45° FOV — 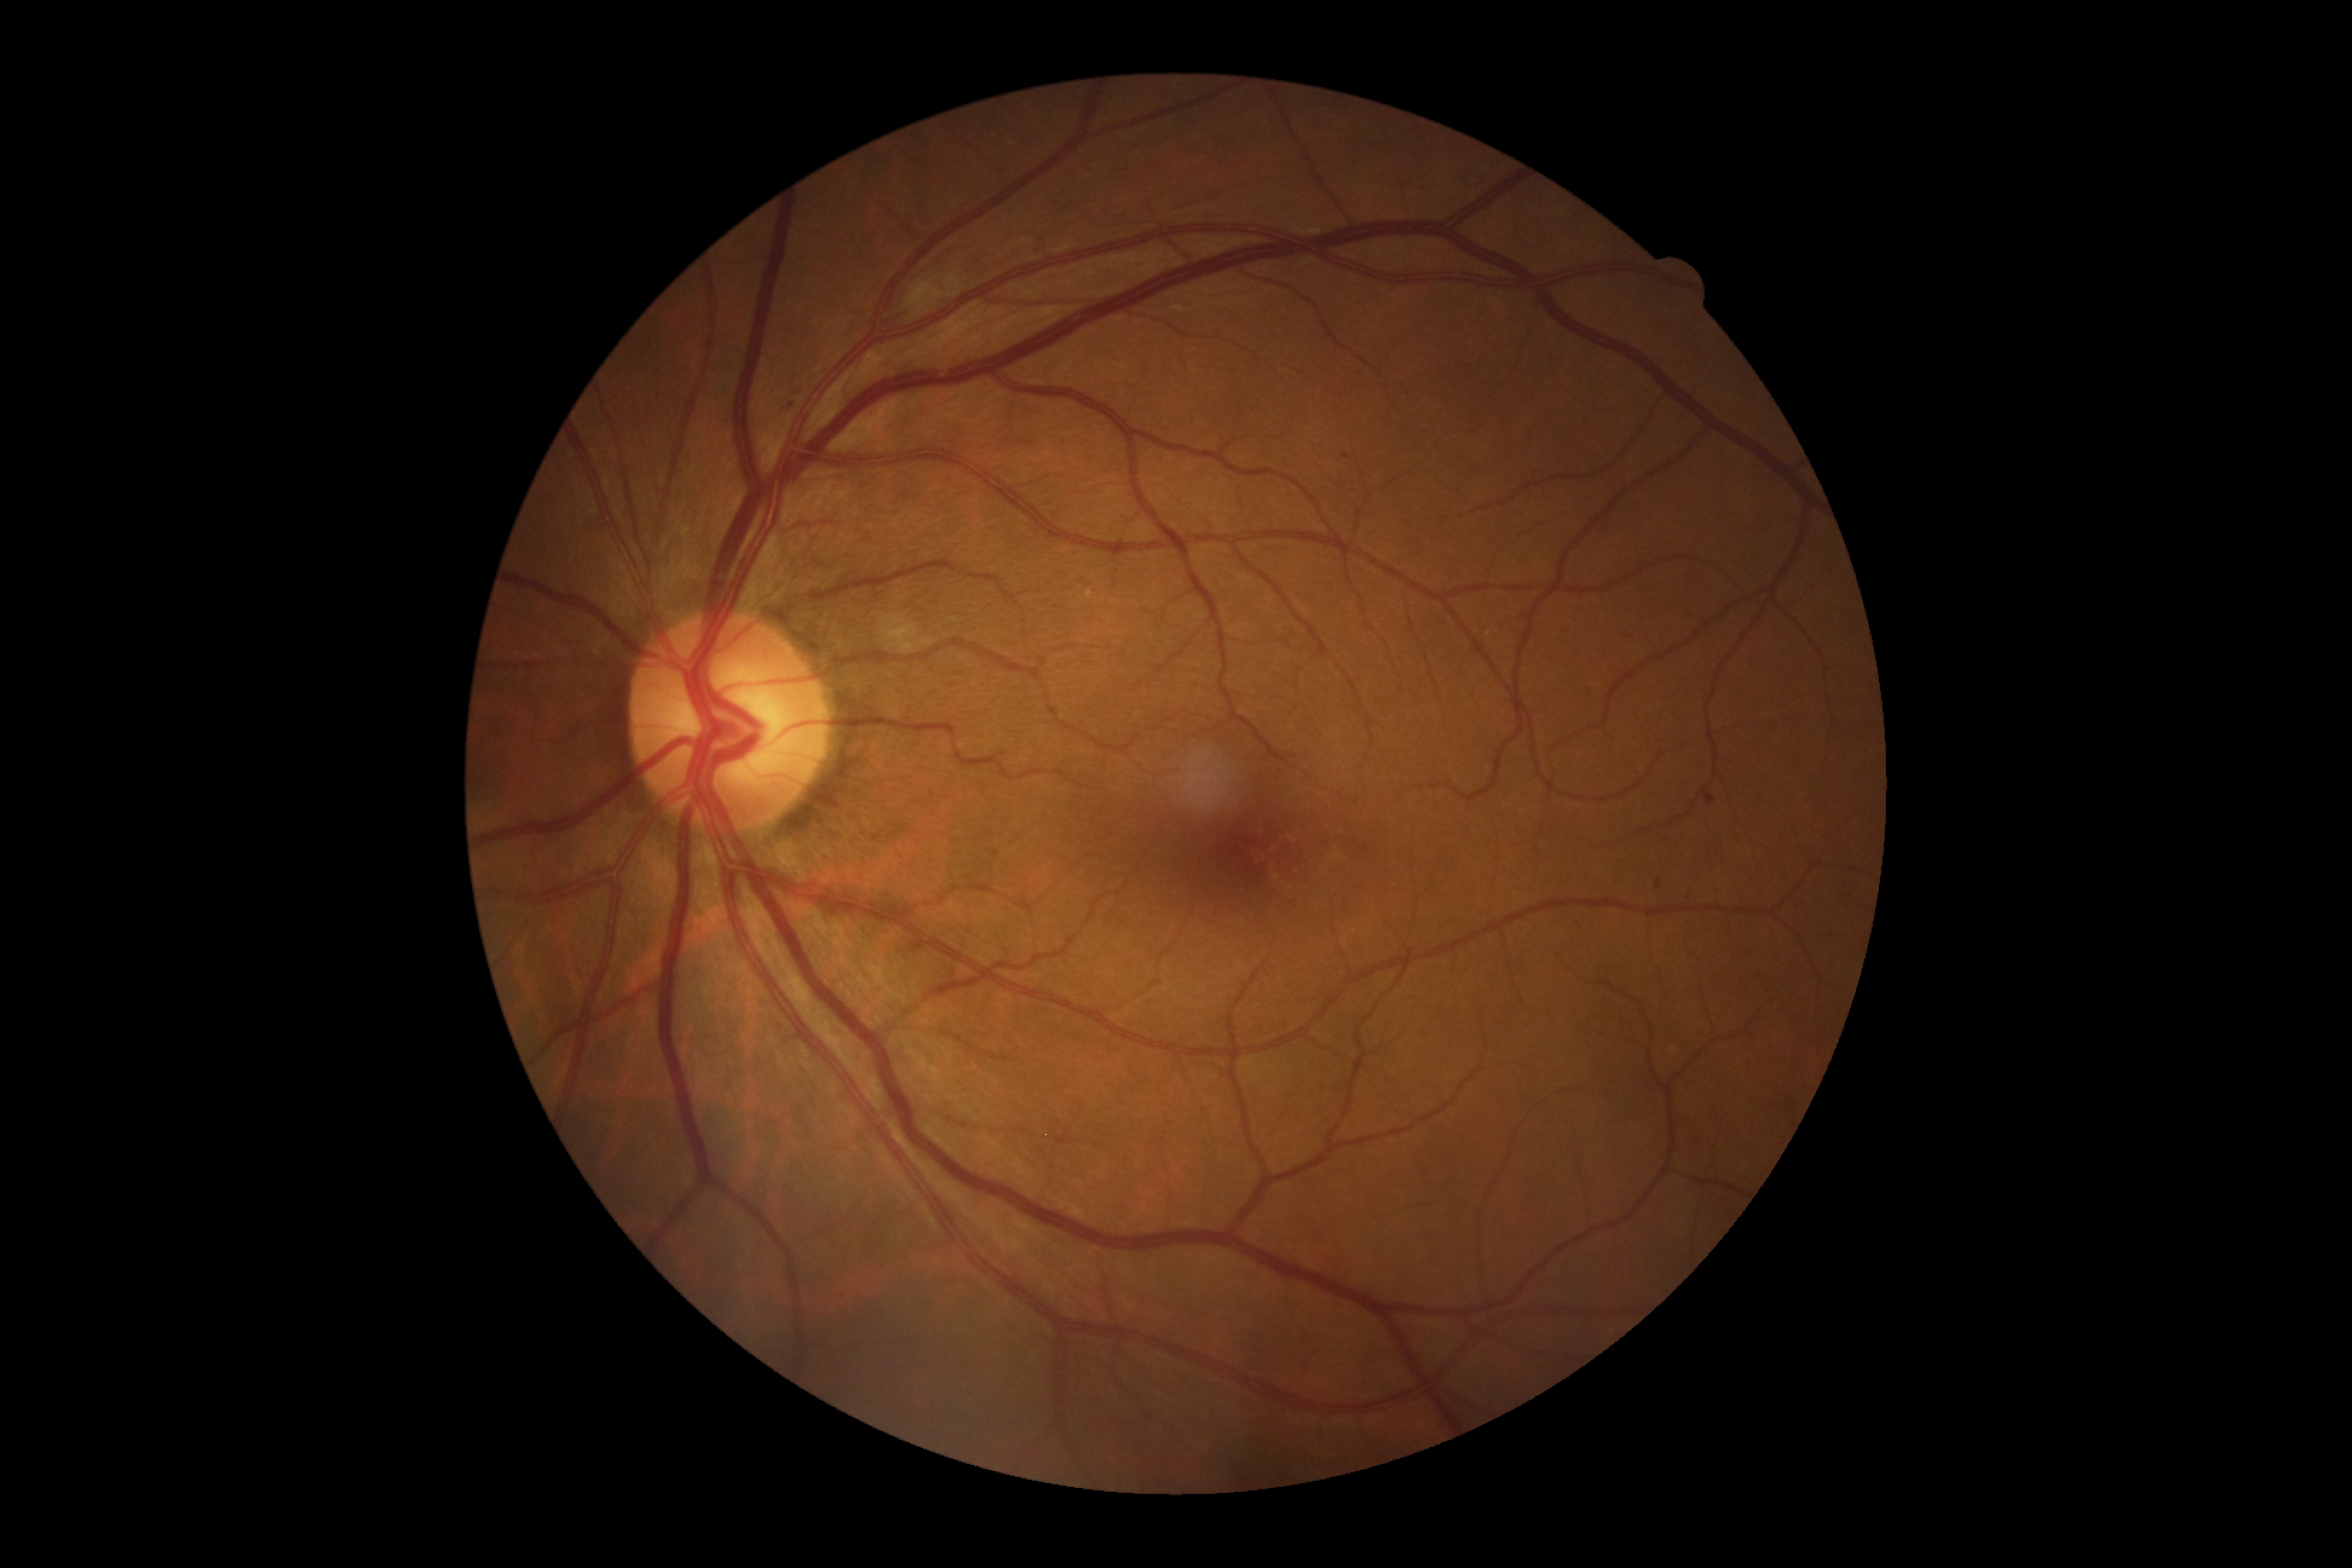

DR class: non-proliferative diabetic retinopathy, DR: grade 2 (moderate NPDR).